Woman patient. Axial length (AL) 23.05 mm. Autorefraction: sphere +0.75 D, cylinder -1 D, axis 85°: 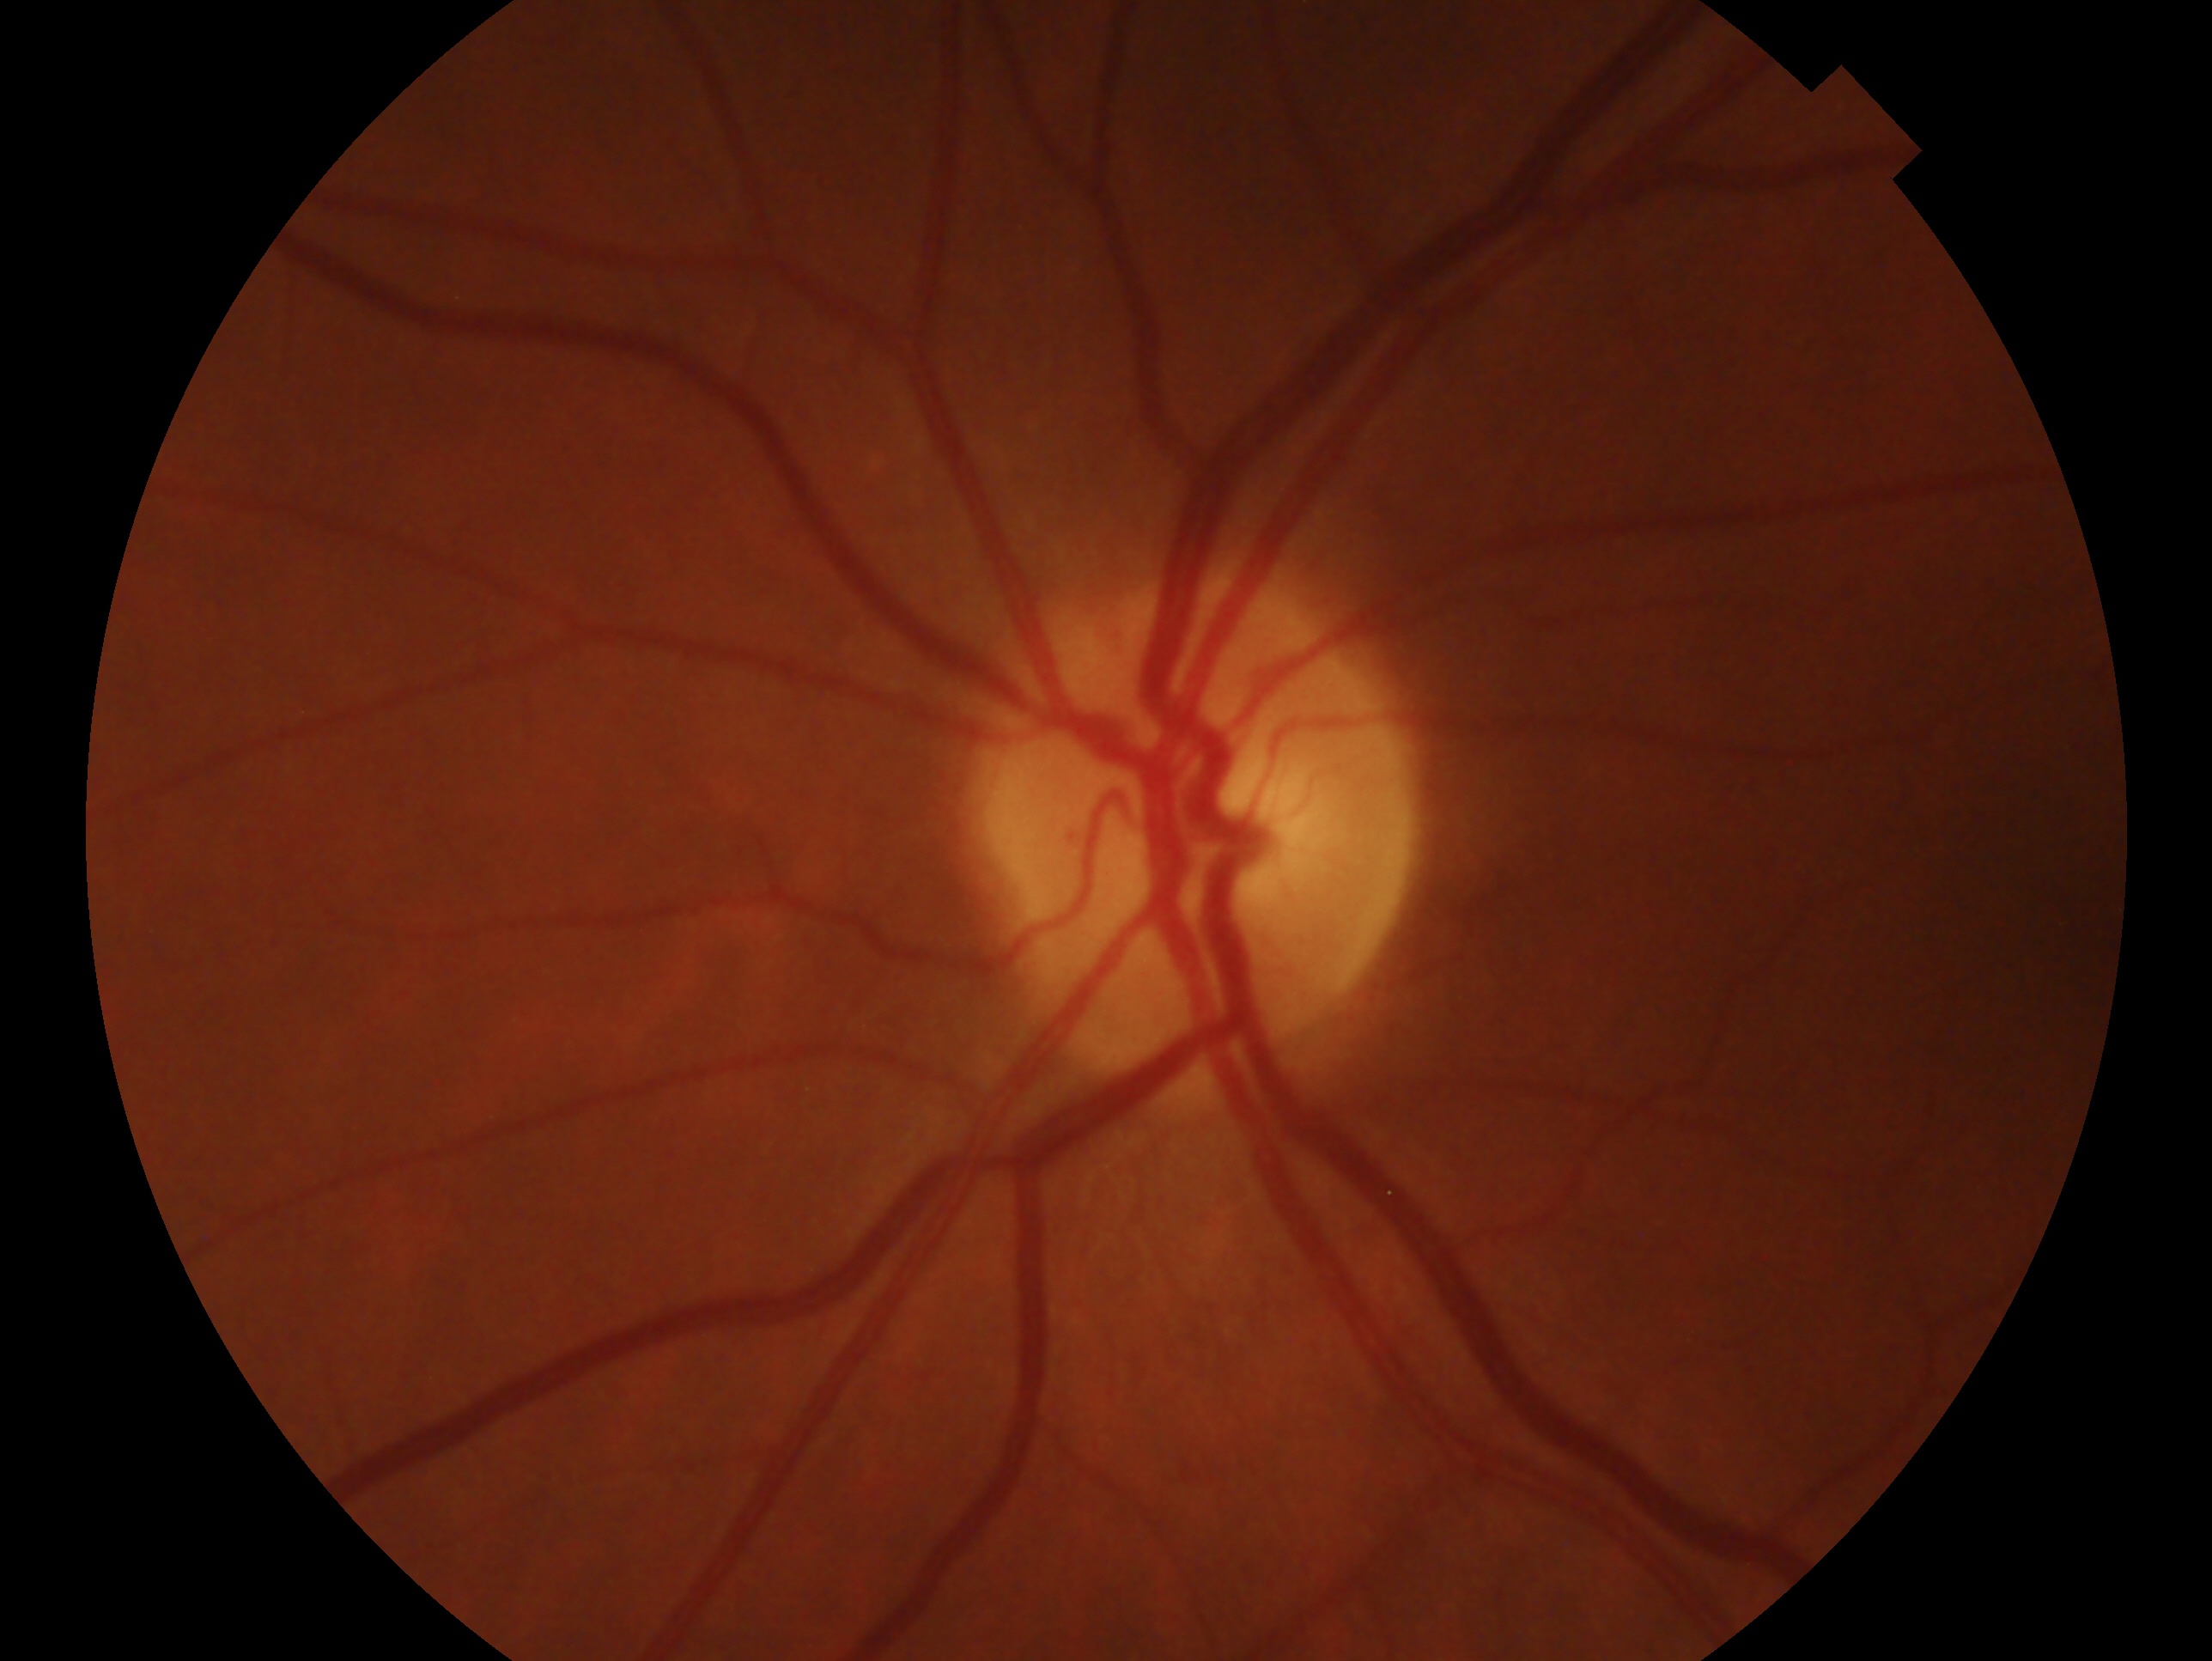 laterality = oculus sinister, glaucoma status = no evidence of glaucoma.